Captured on a Remidio smartphone fundus camera. Fundus photo. 1659 by 2212 pixels
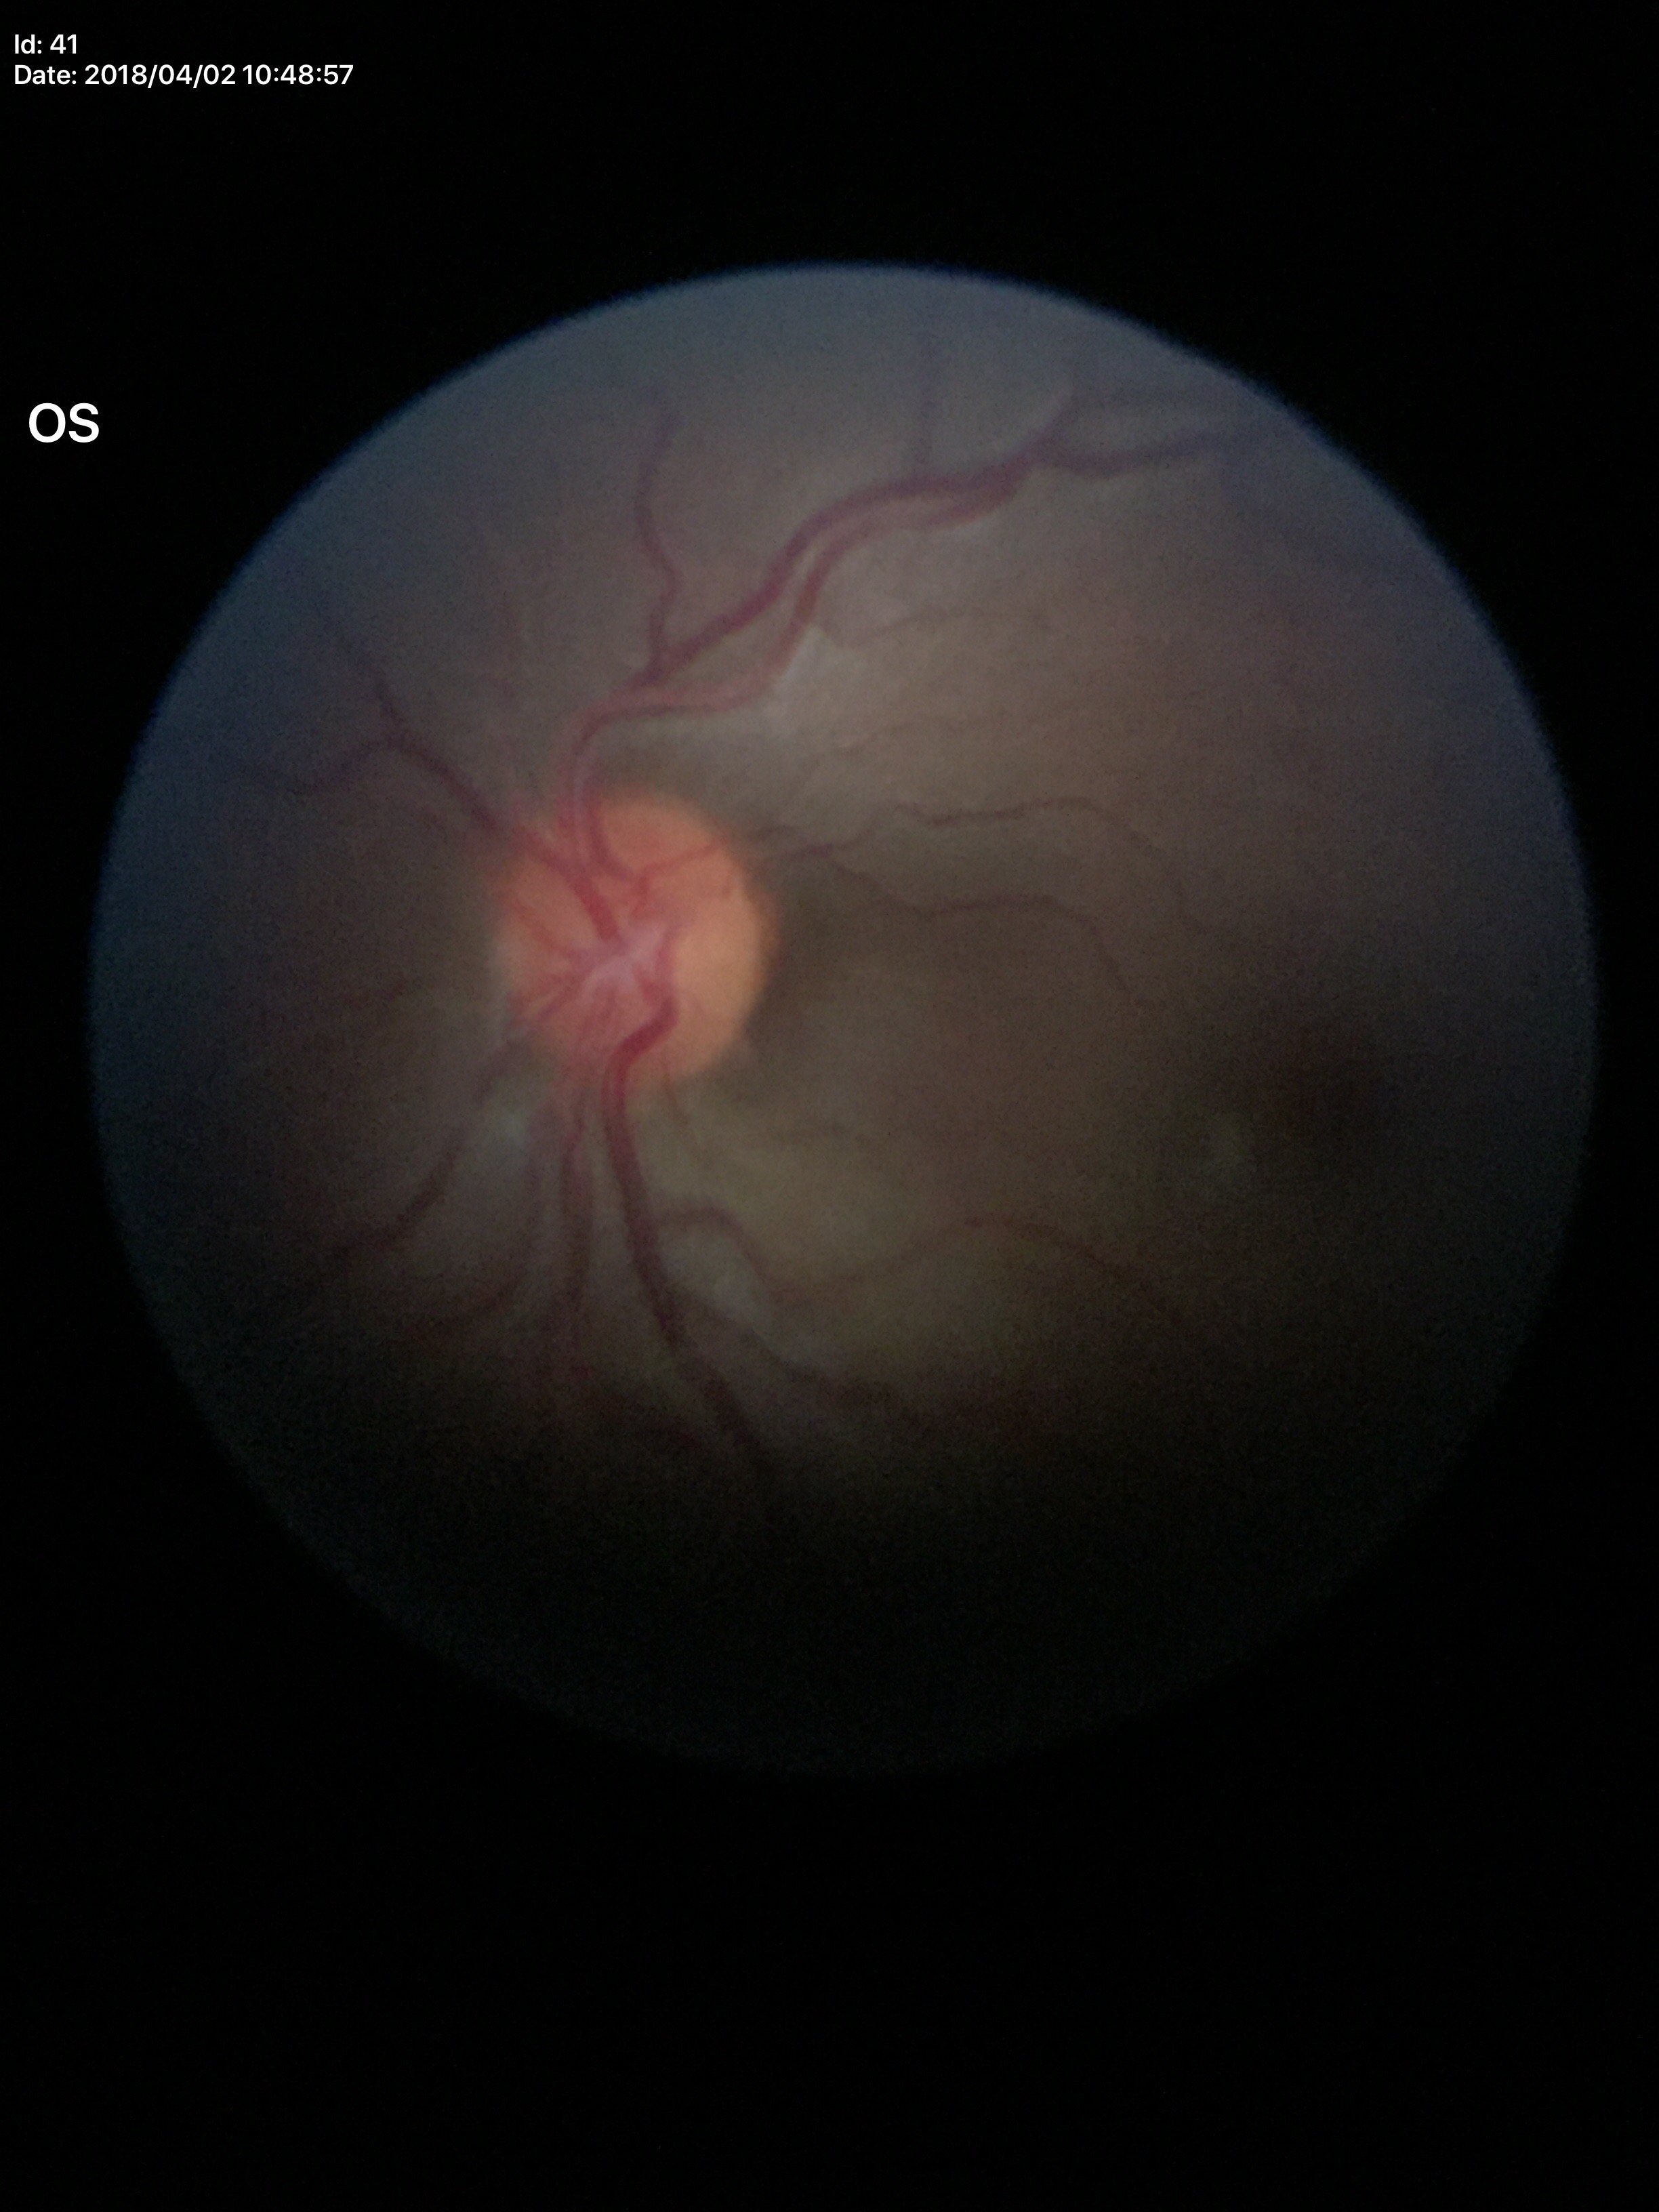 * vertical cup-to-disc ratio (VCDR) — 0.42
* Glaucoma impression — no suspicious findings